Wide-field fundus photograph of an infant: 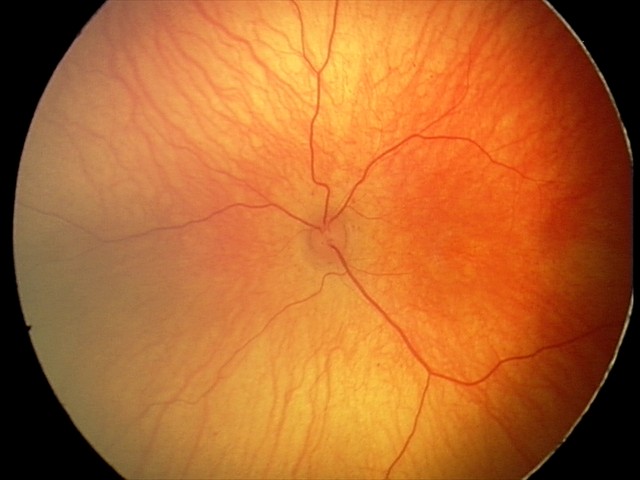

Q: What is the screening diagnosis?
A: normal retinal appearance